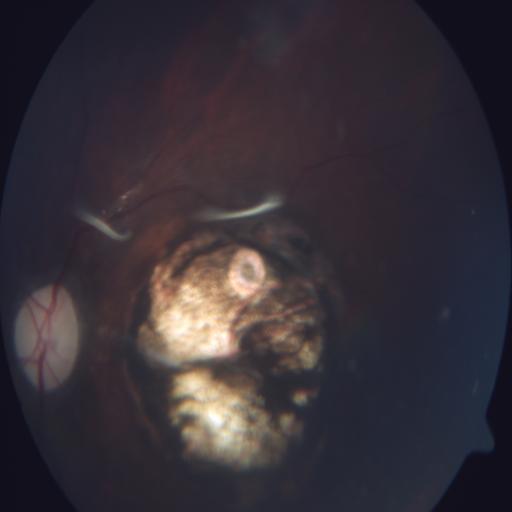
Diagnosis (2):
- coloboma
- optic disc pallor